45-degree field of view.
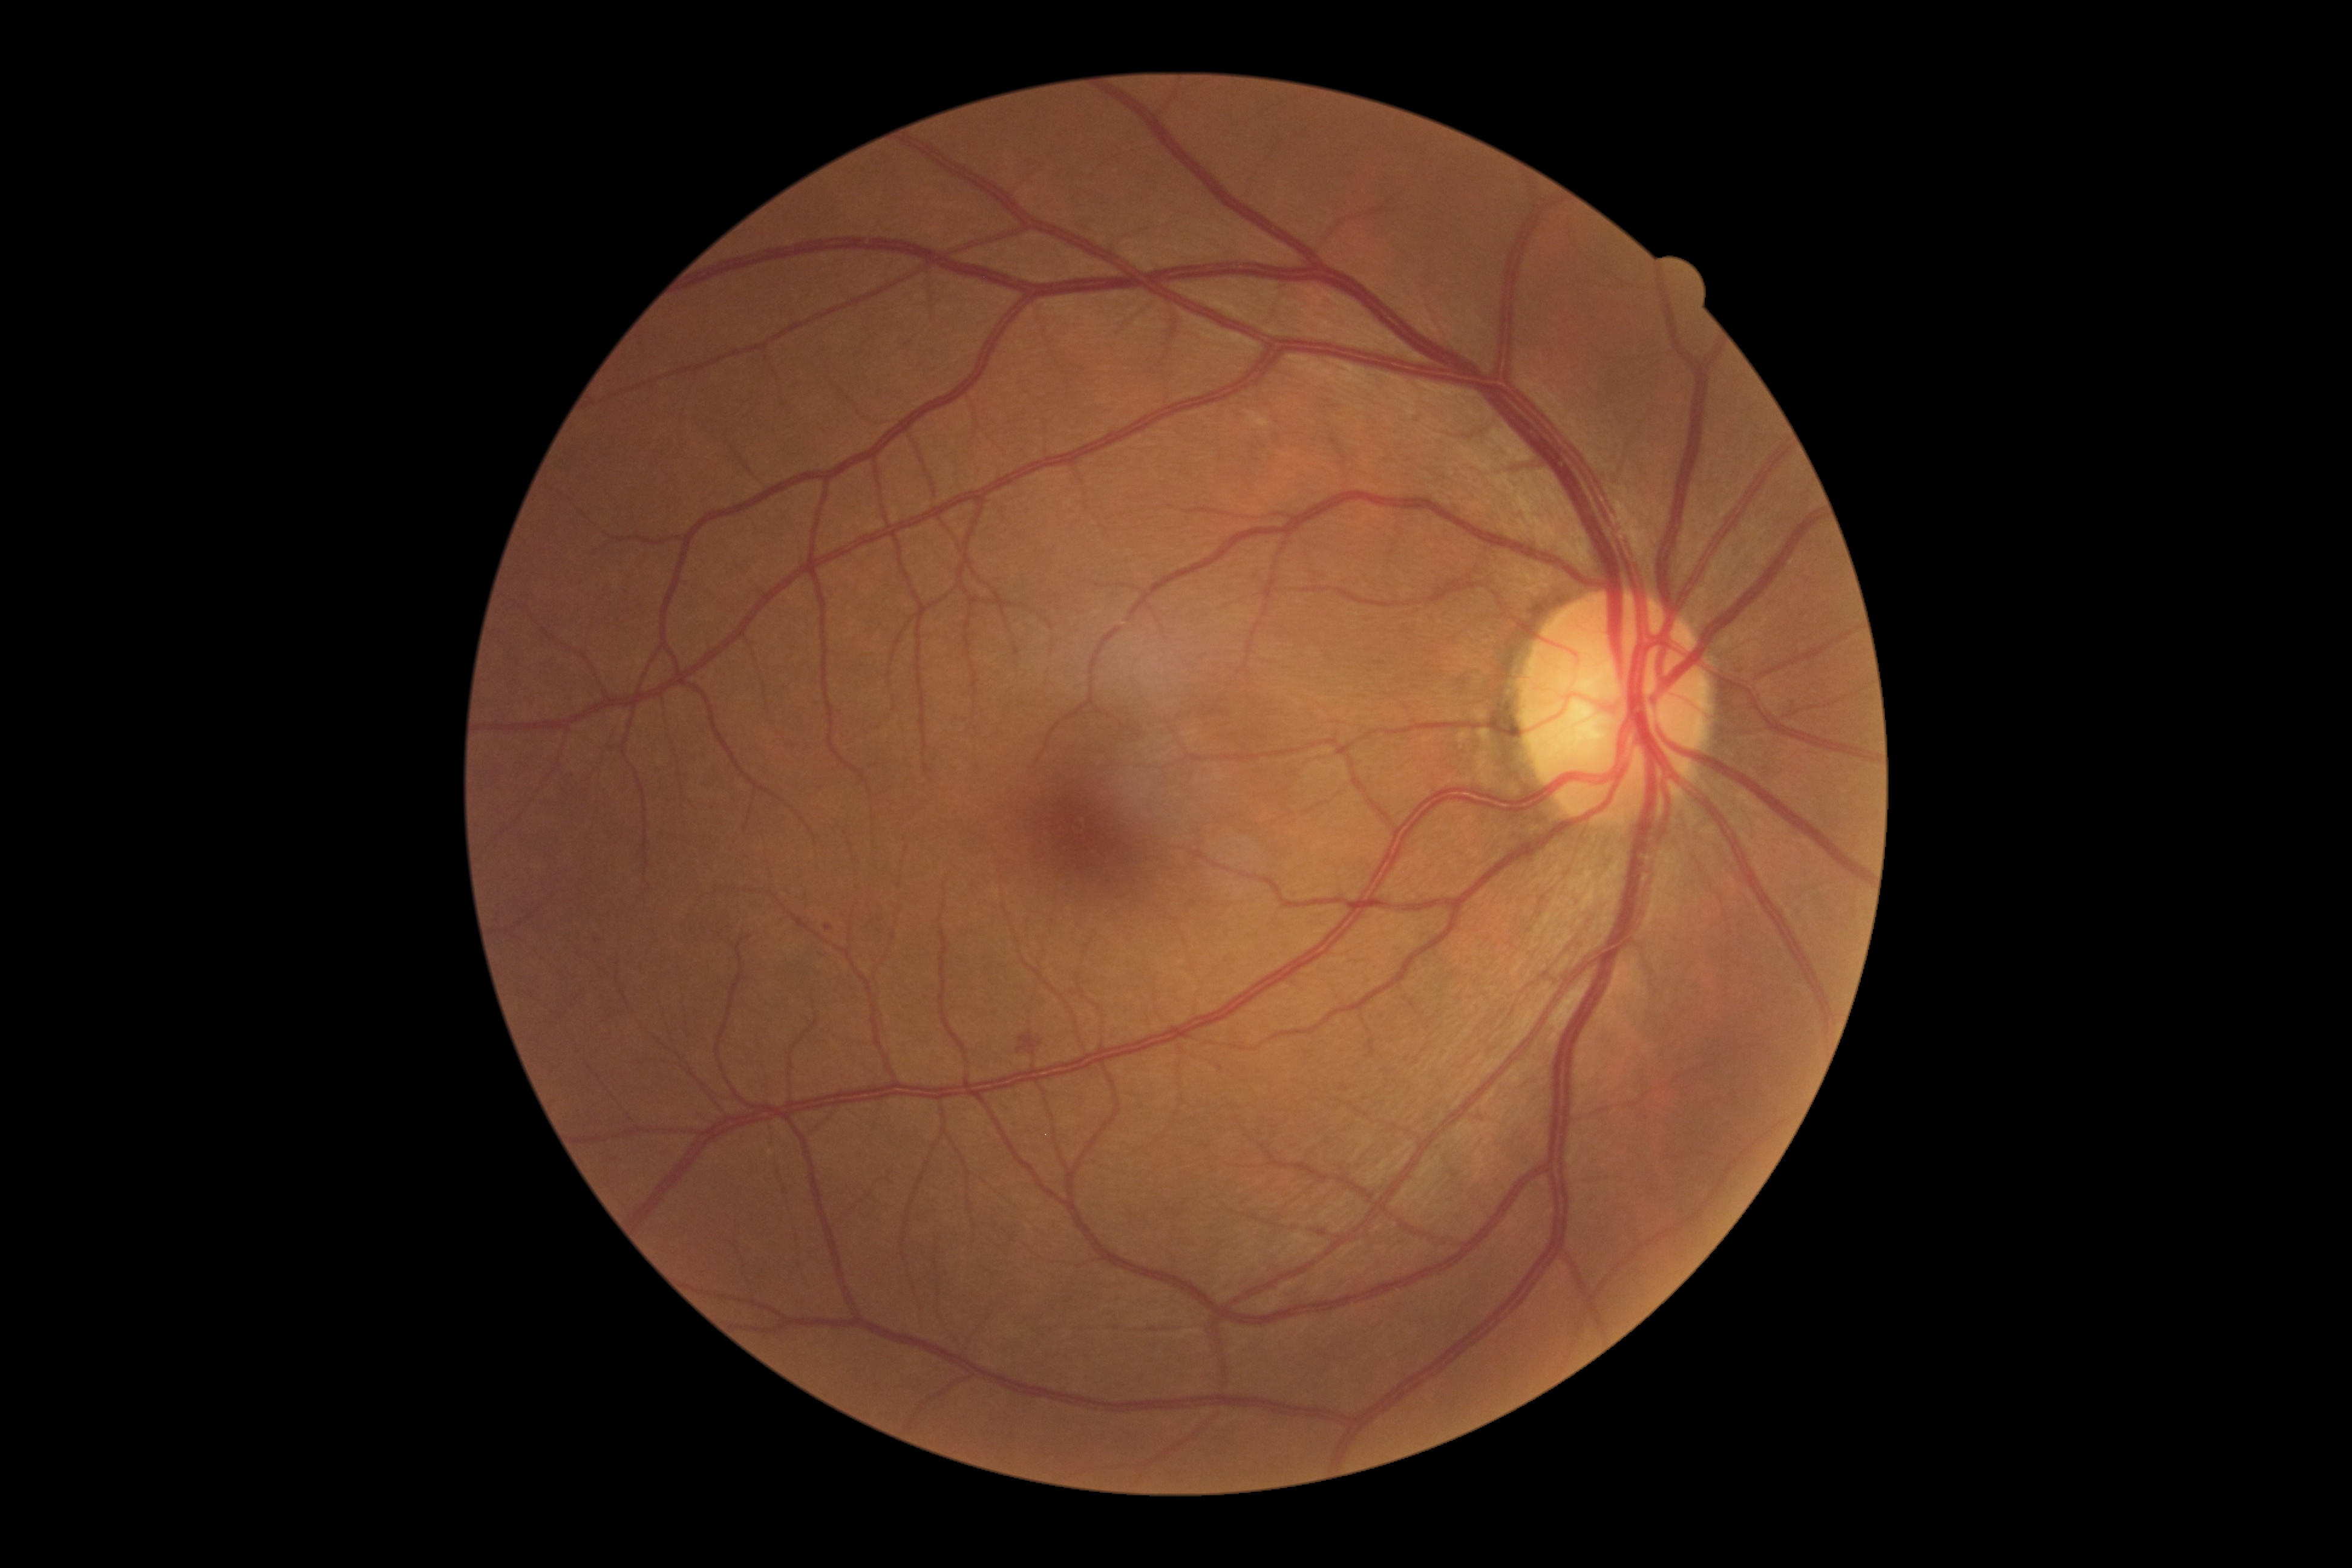
{
  "dr_category": "non-proliferative diabetic retinopathy",
  "dr_grade": "grade 2 — more than just microaneurysms but less than severe NPDR"
}